Color fundus image — 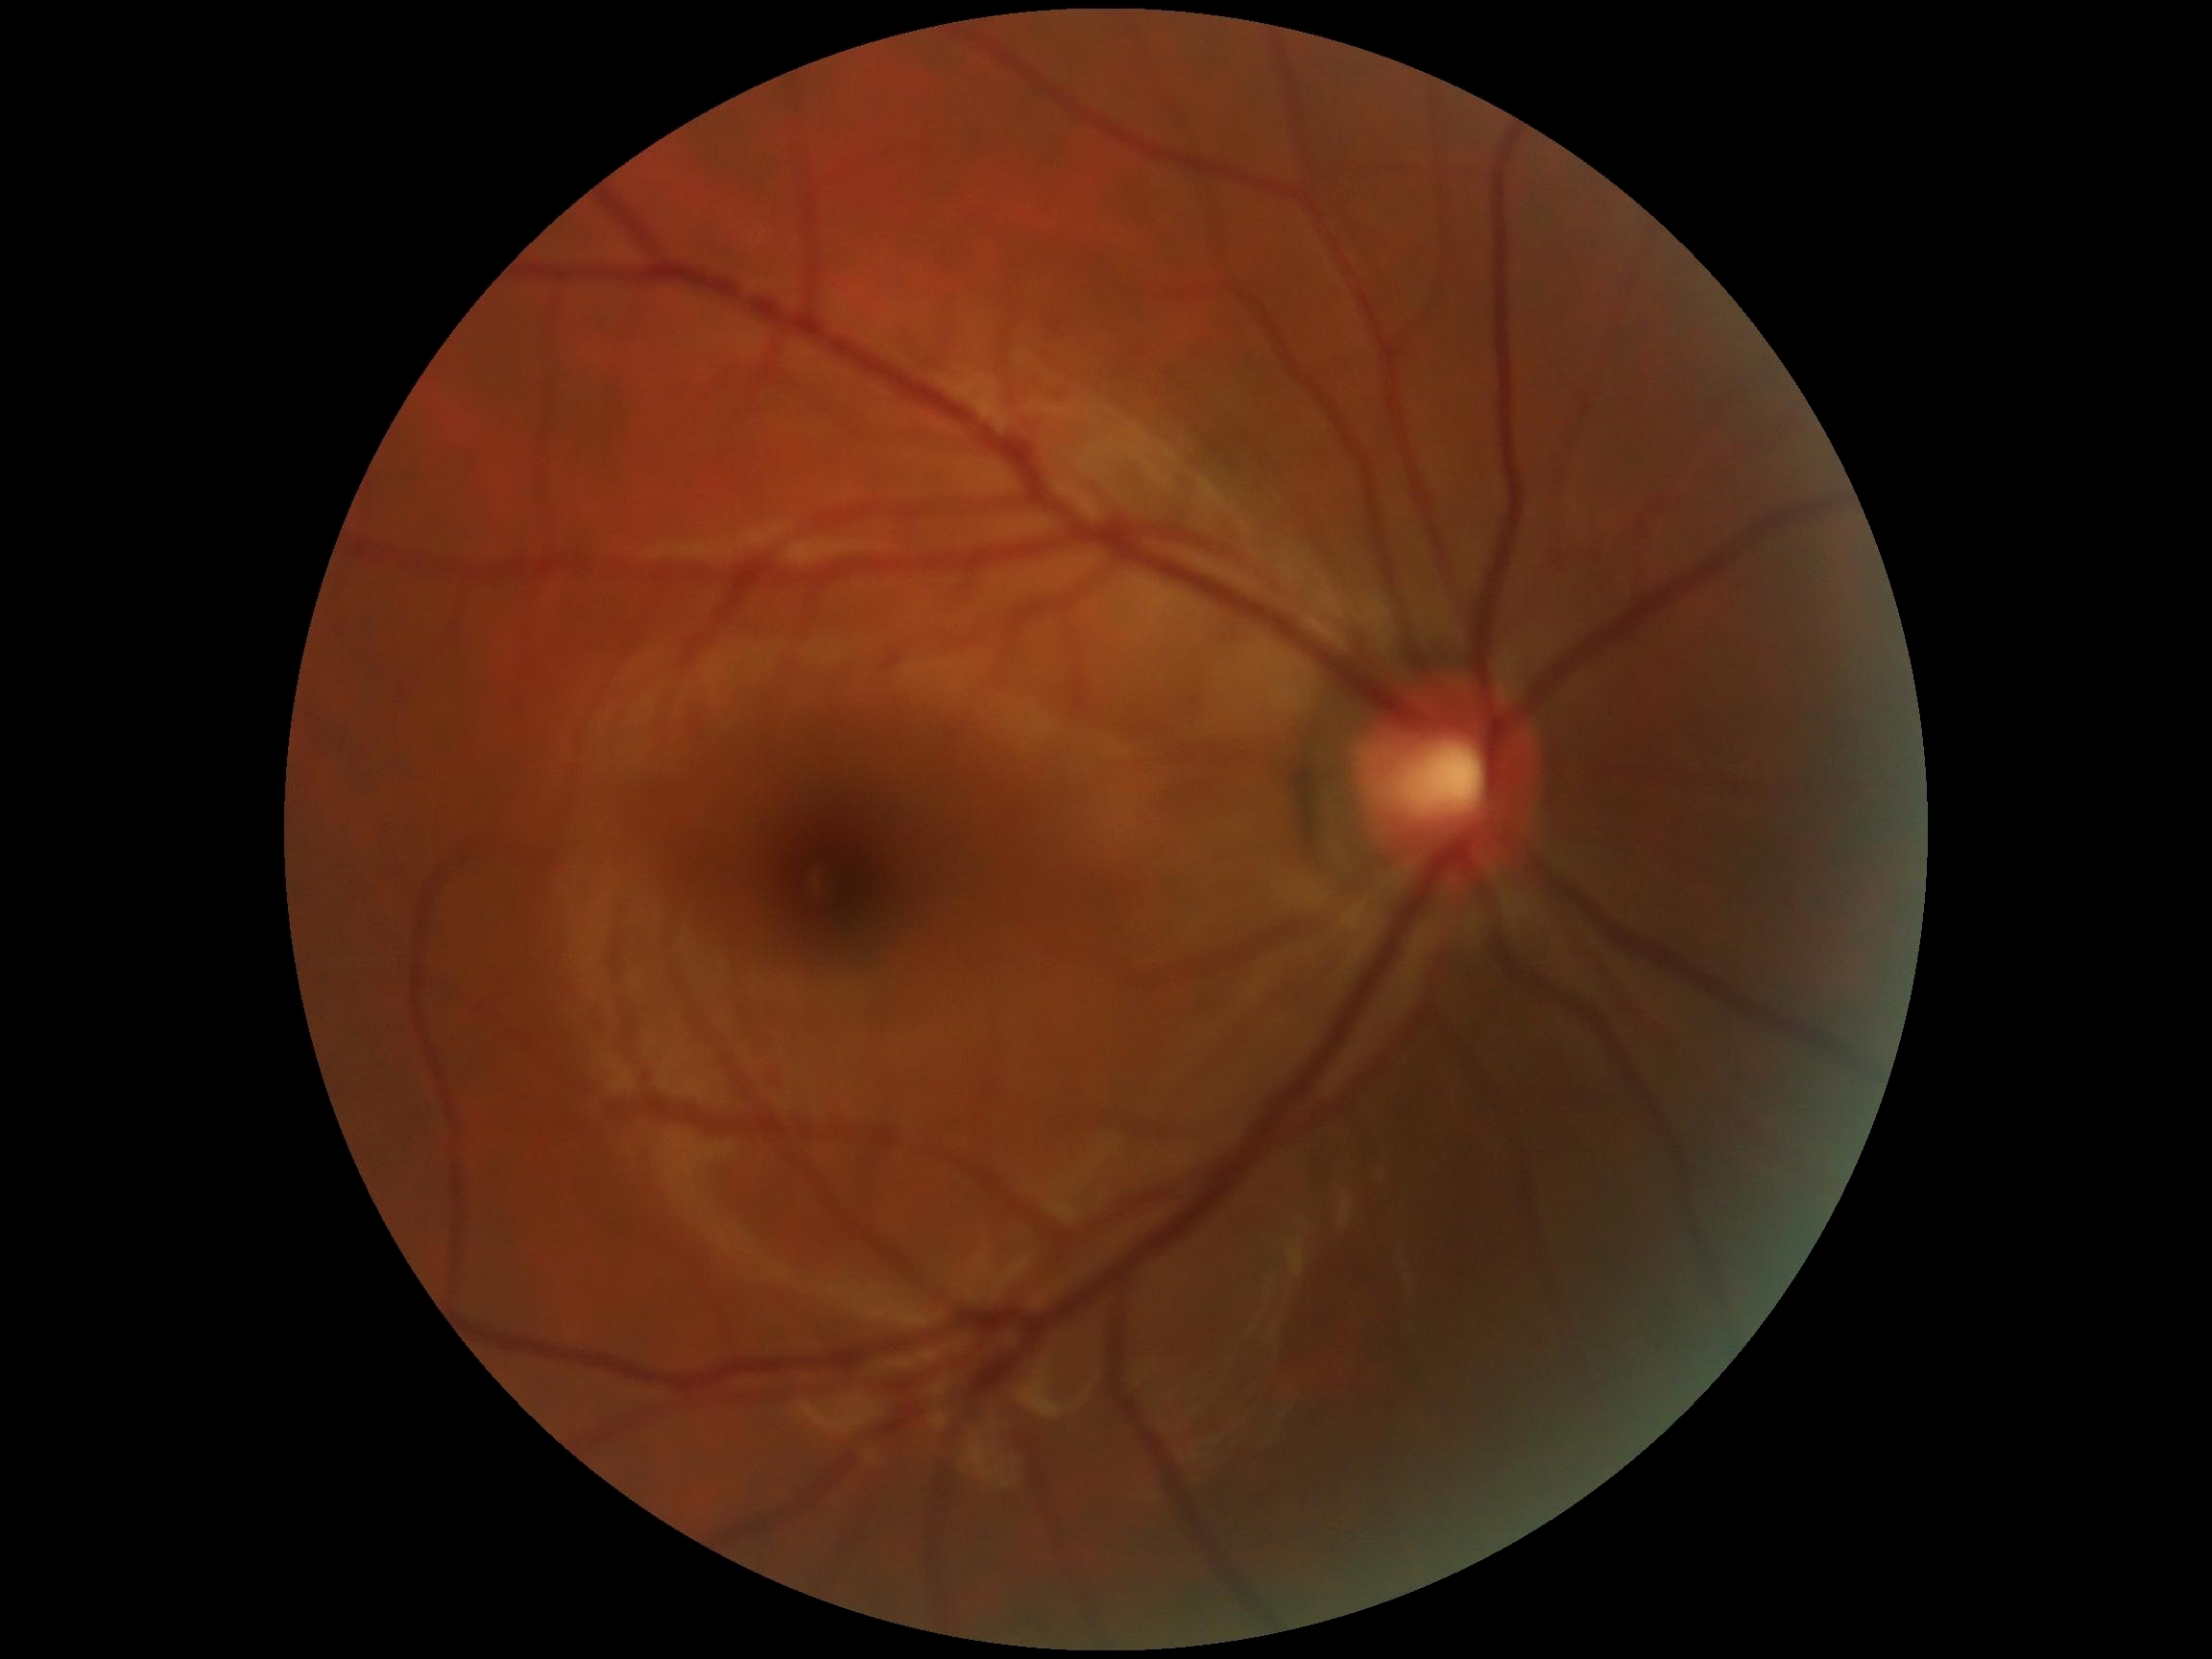
DR is no apparent retinopathy (grade 0). No signs of diabetic retinopathy.